Without pupil dilation; DR severity per modified Davis staging; camera: NIDEK AFC-230
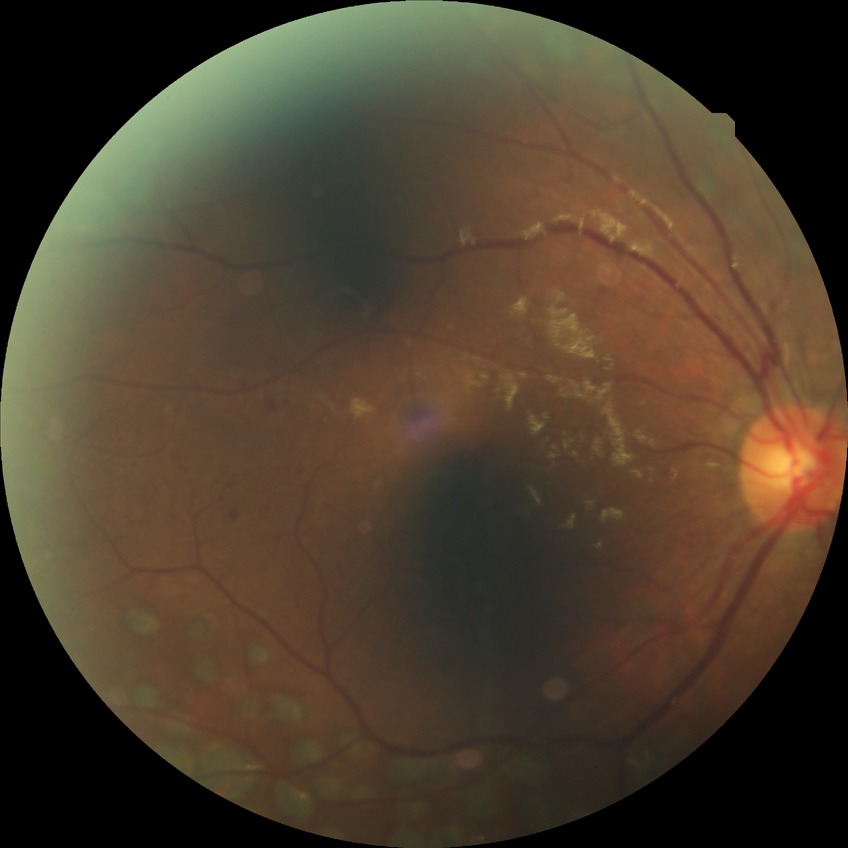 Diabetic retinopathy (DR) is proliferative diabetic retinopathy (PDR).